Tabletop color fundus camera image; 50° field of view:
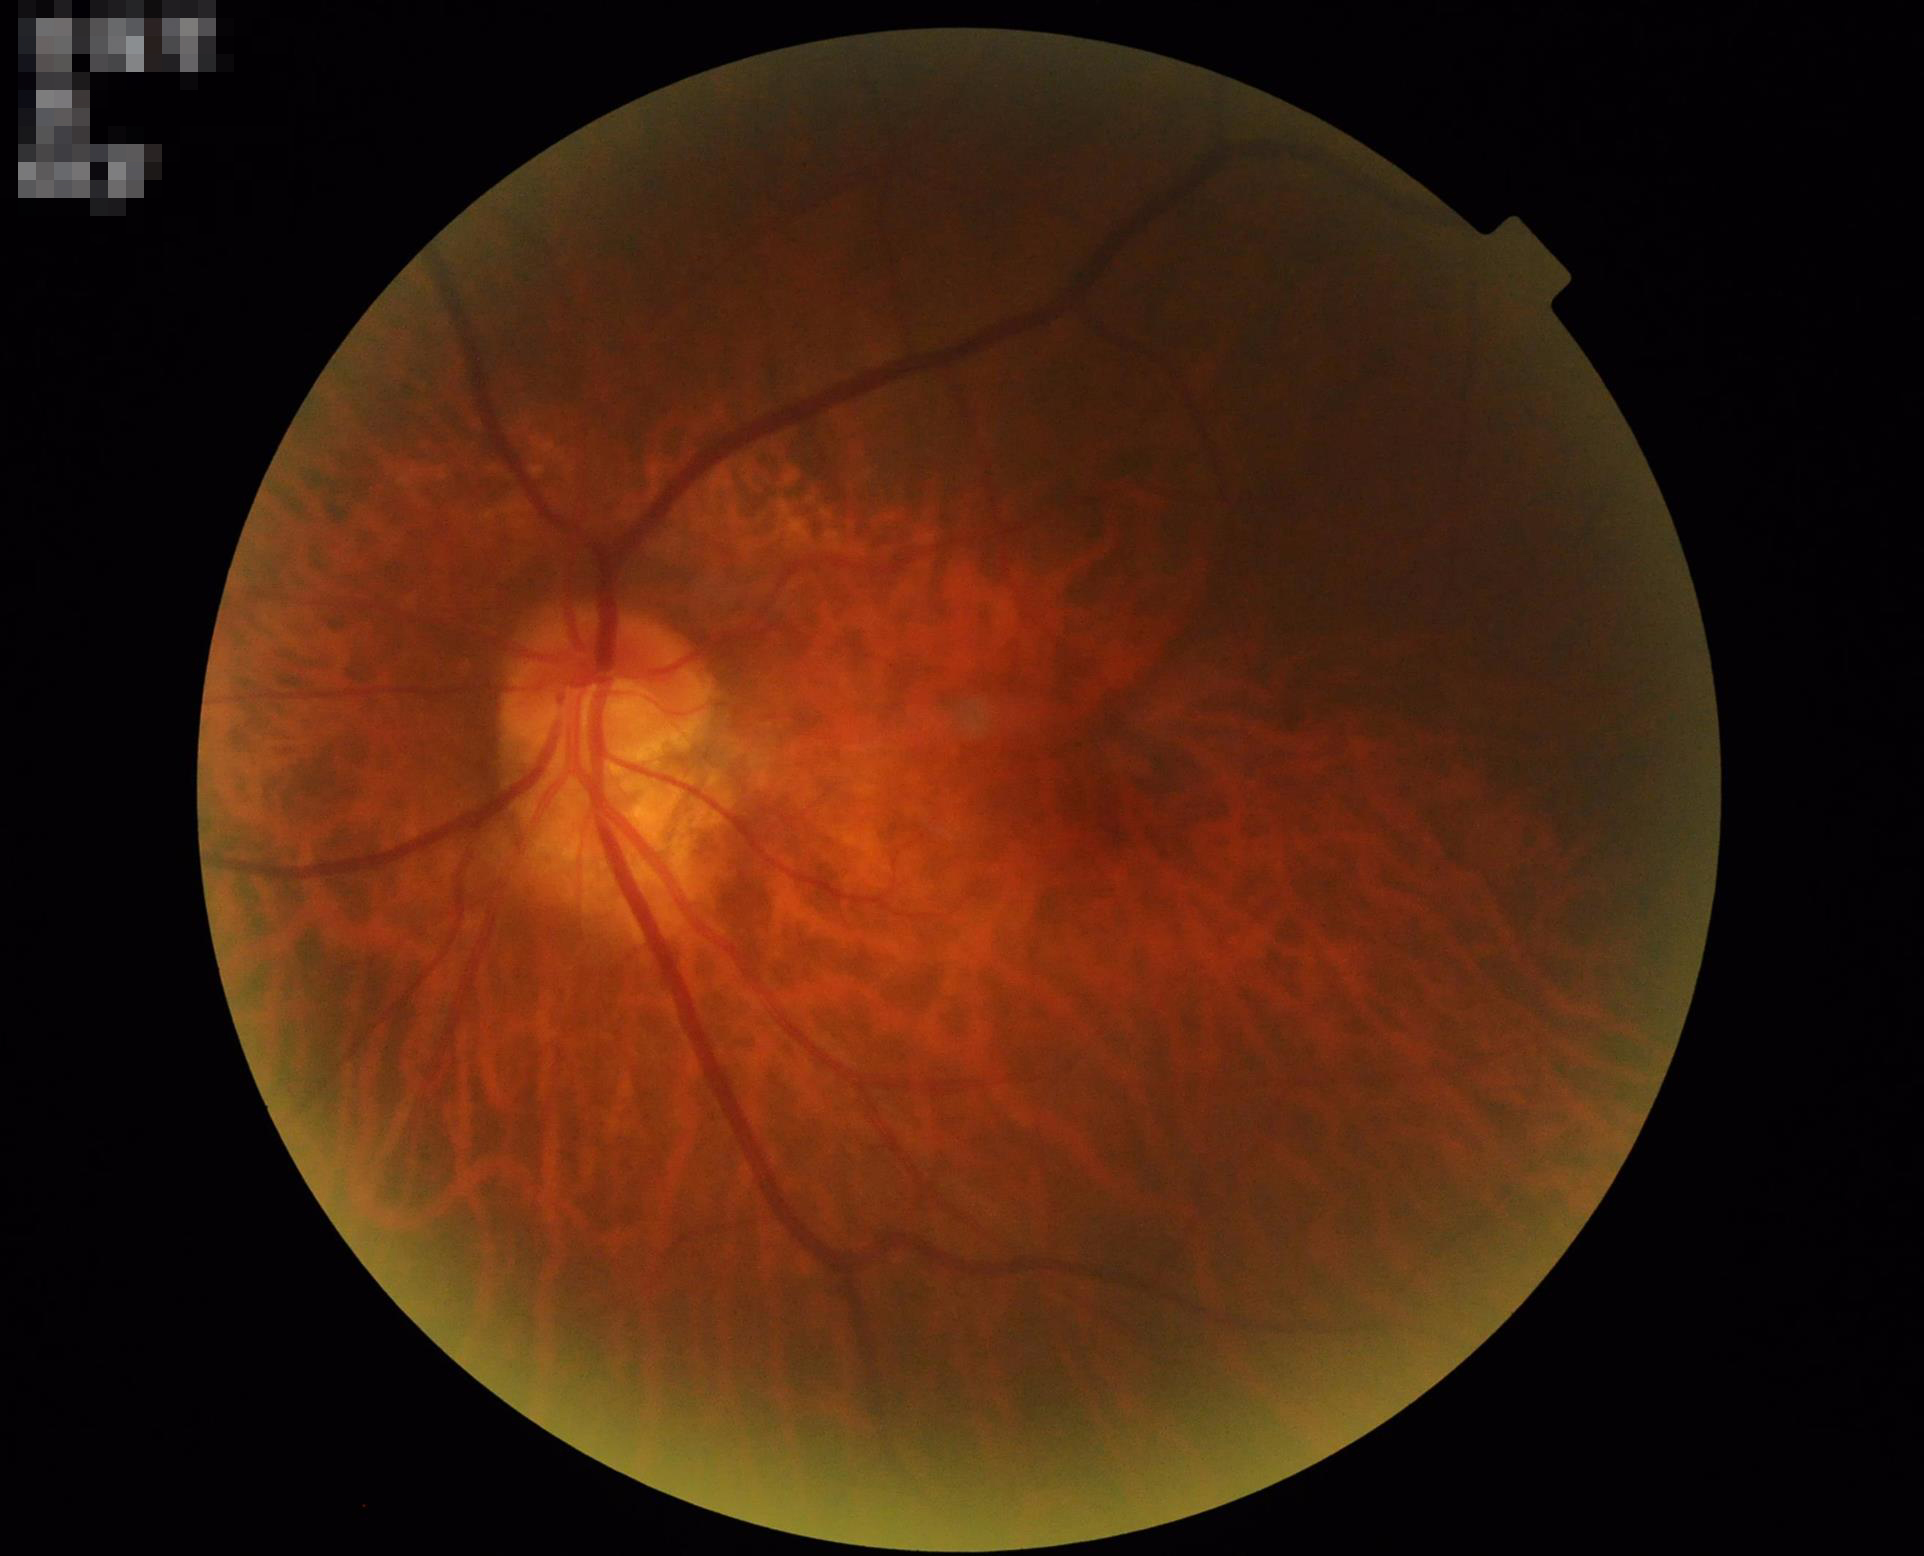

Quality grading: illumination: over- or under-exposed | overall: inadequate for clinical interpretation | contrast: good dynamic range | clarity: optic disc, vessels, and background in focus.